848 x 848 pixels, NIDEK AFC-230, 45° FOV, modified Davis grading, nonmydriatic.
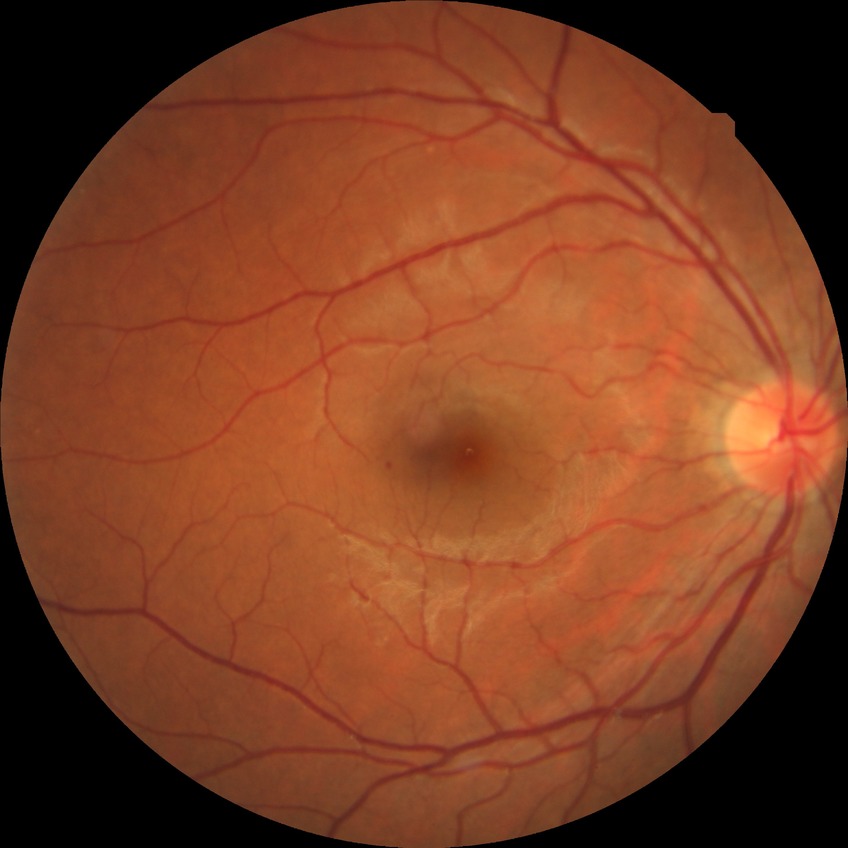
diabetic retinopathy (DR): no diabetic retinopathy (NDR).